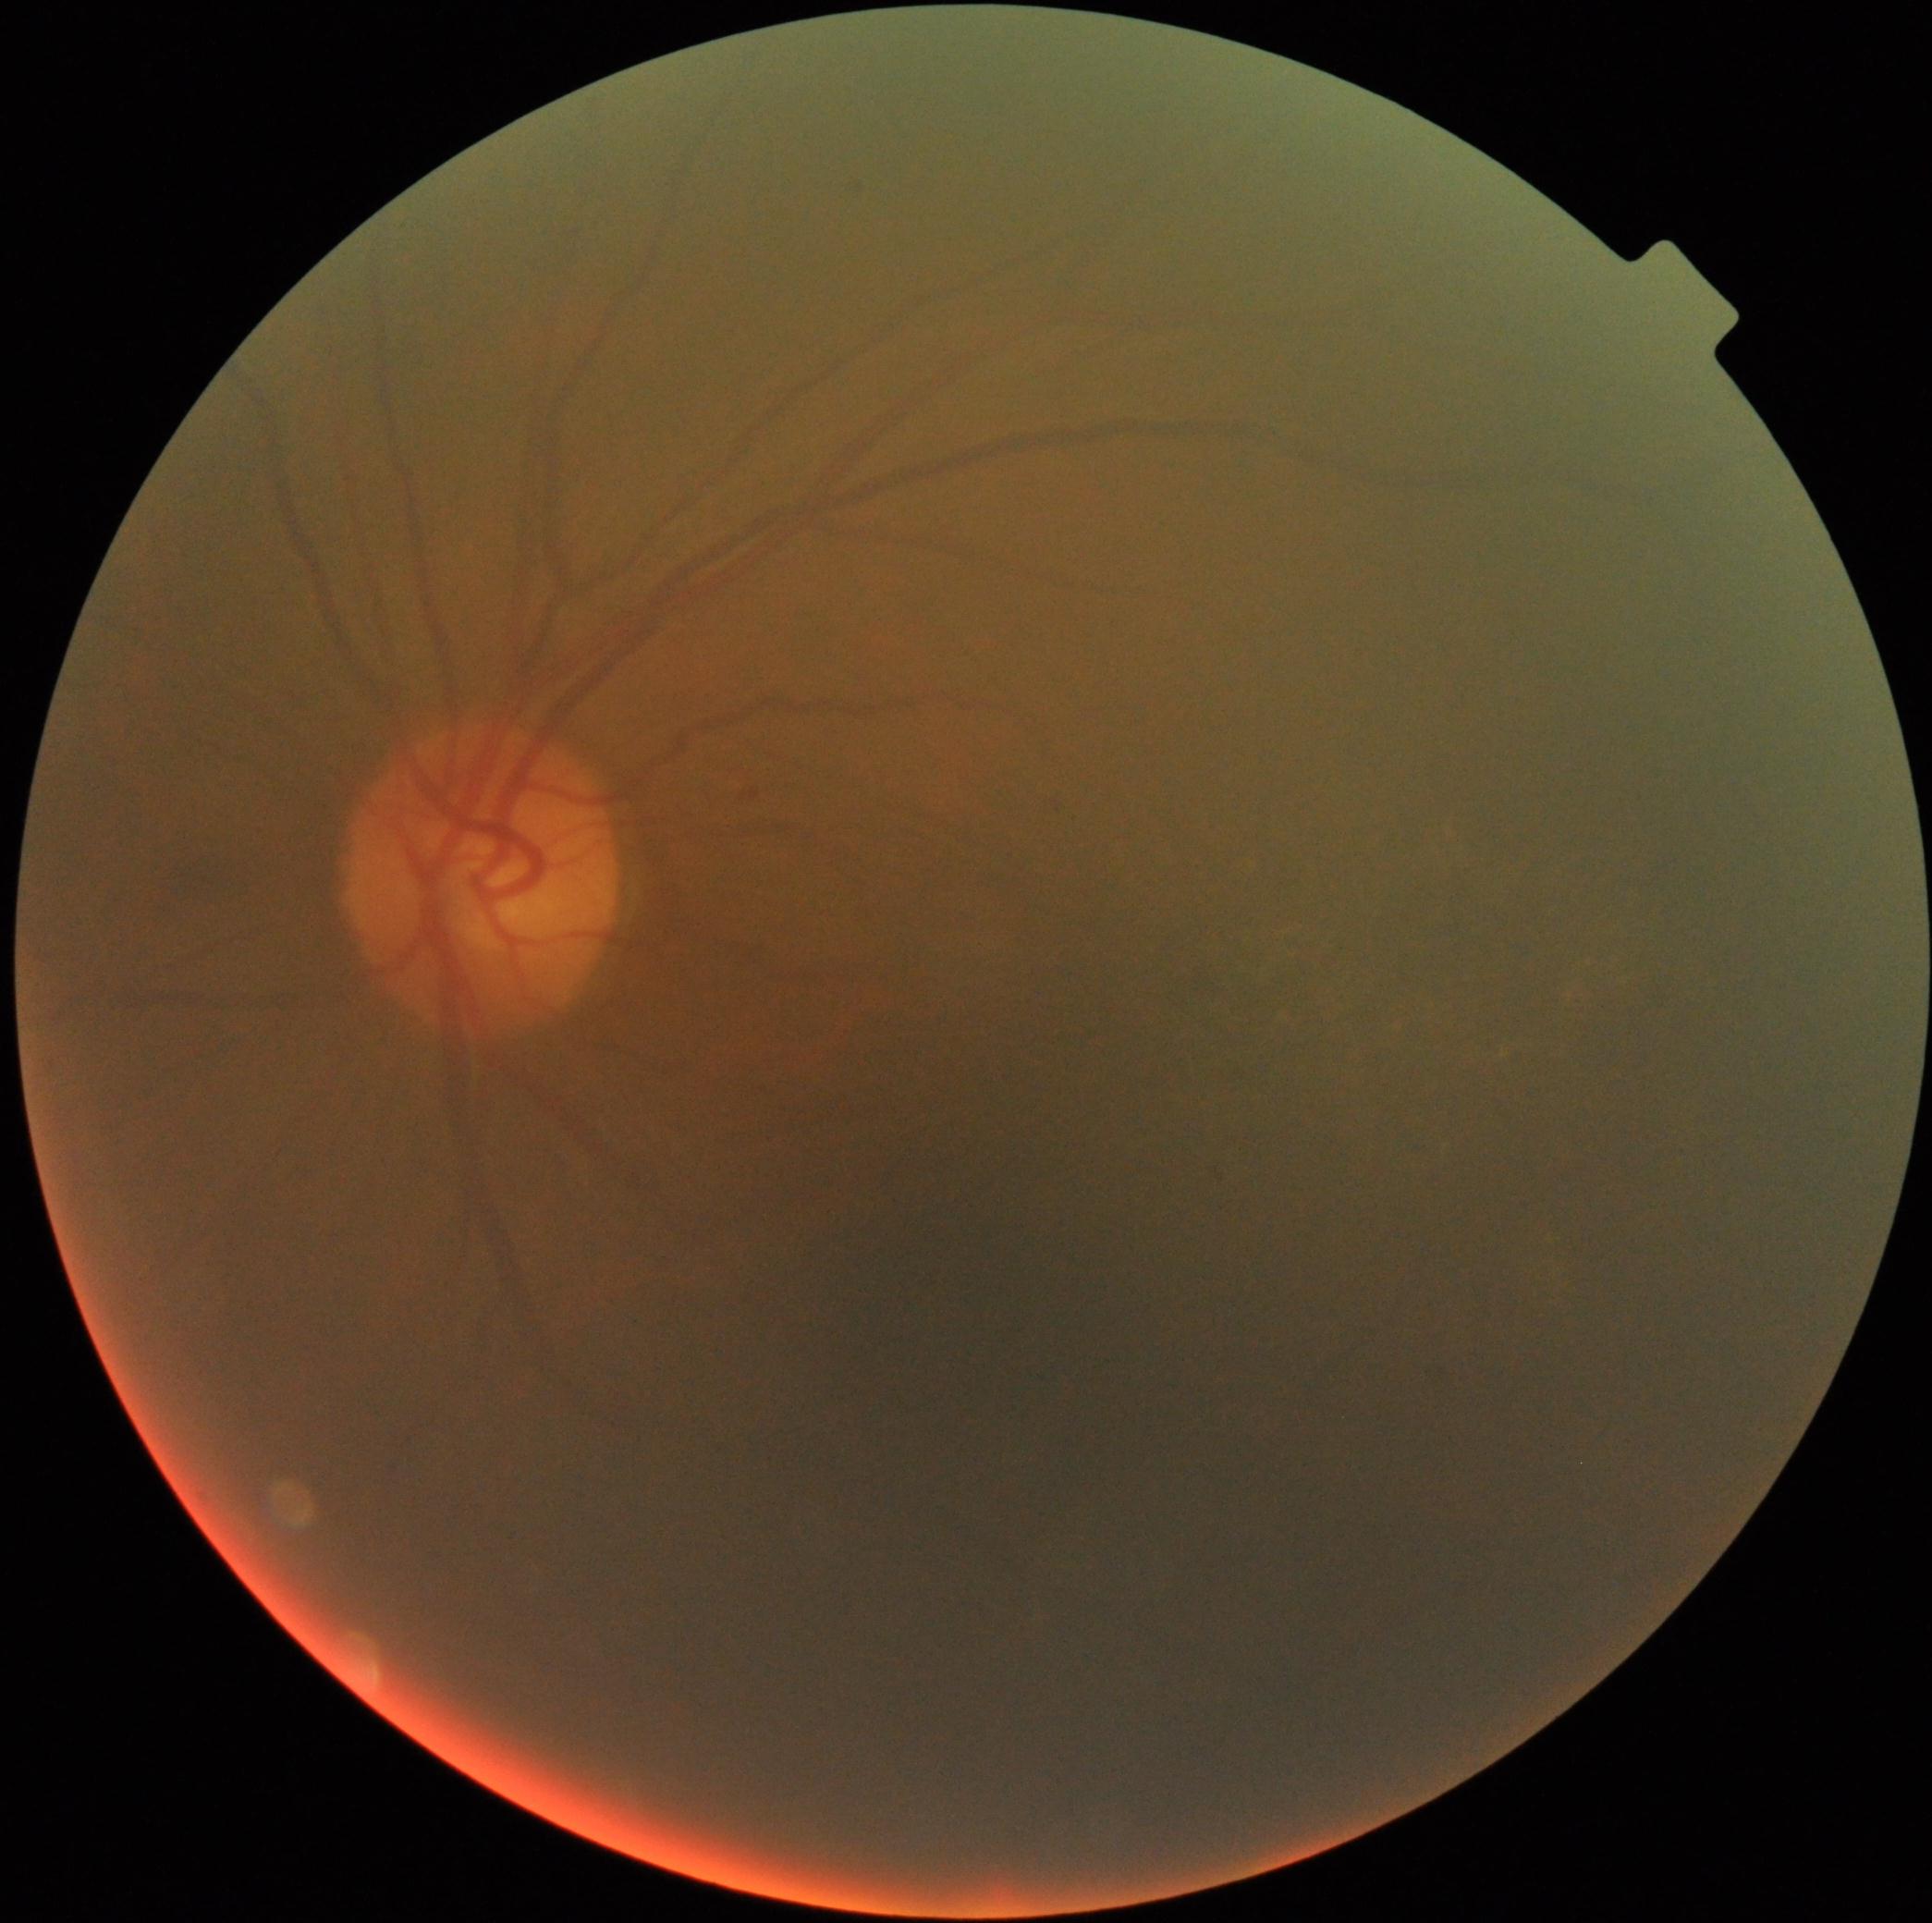
DR severity: grade 2 (moderate NPDR).